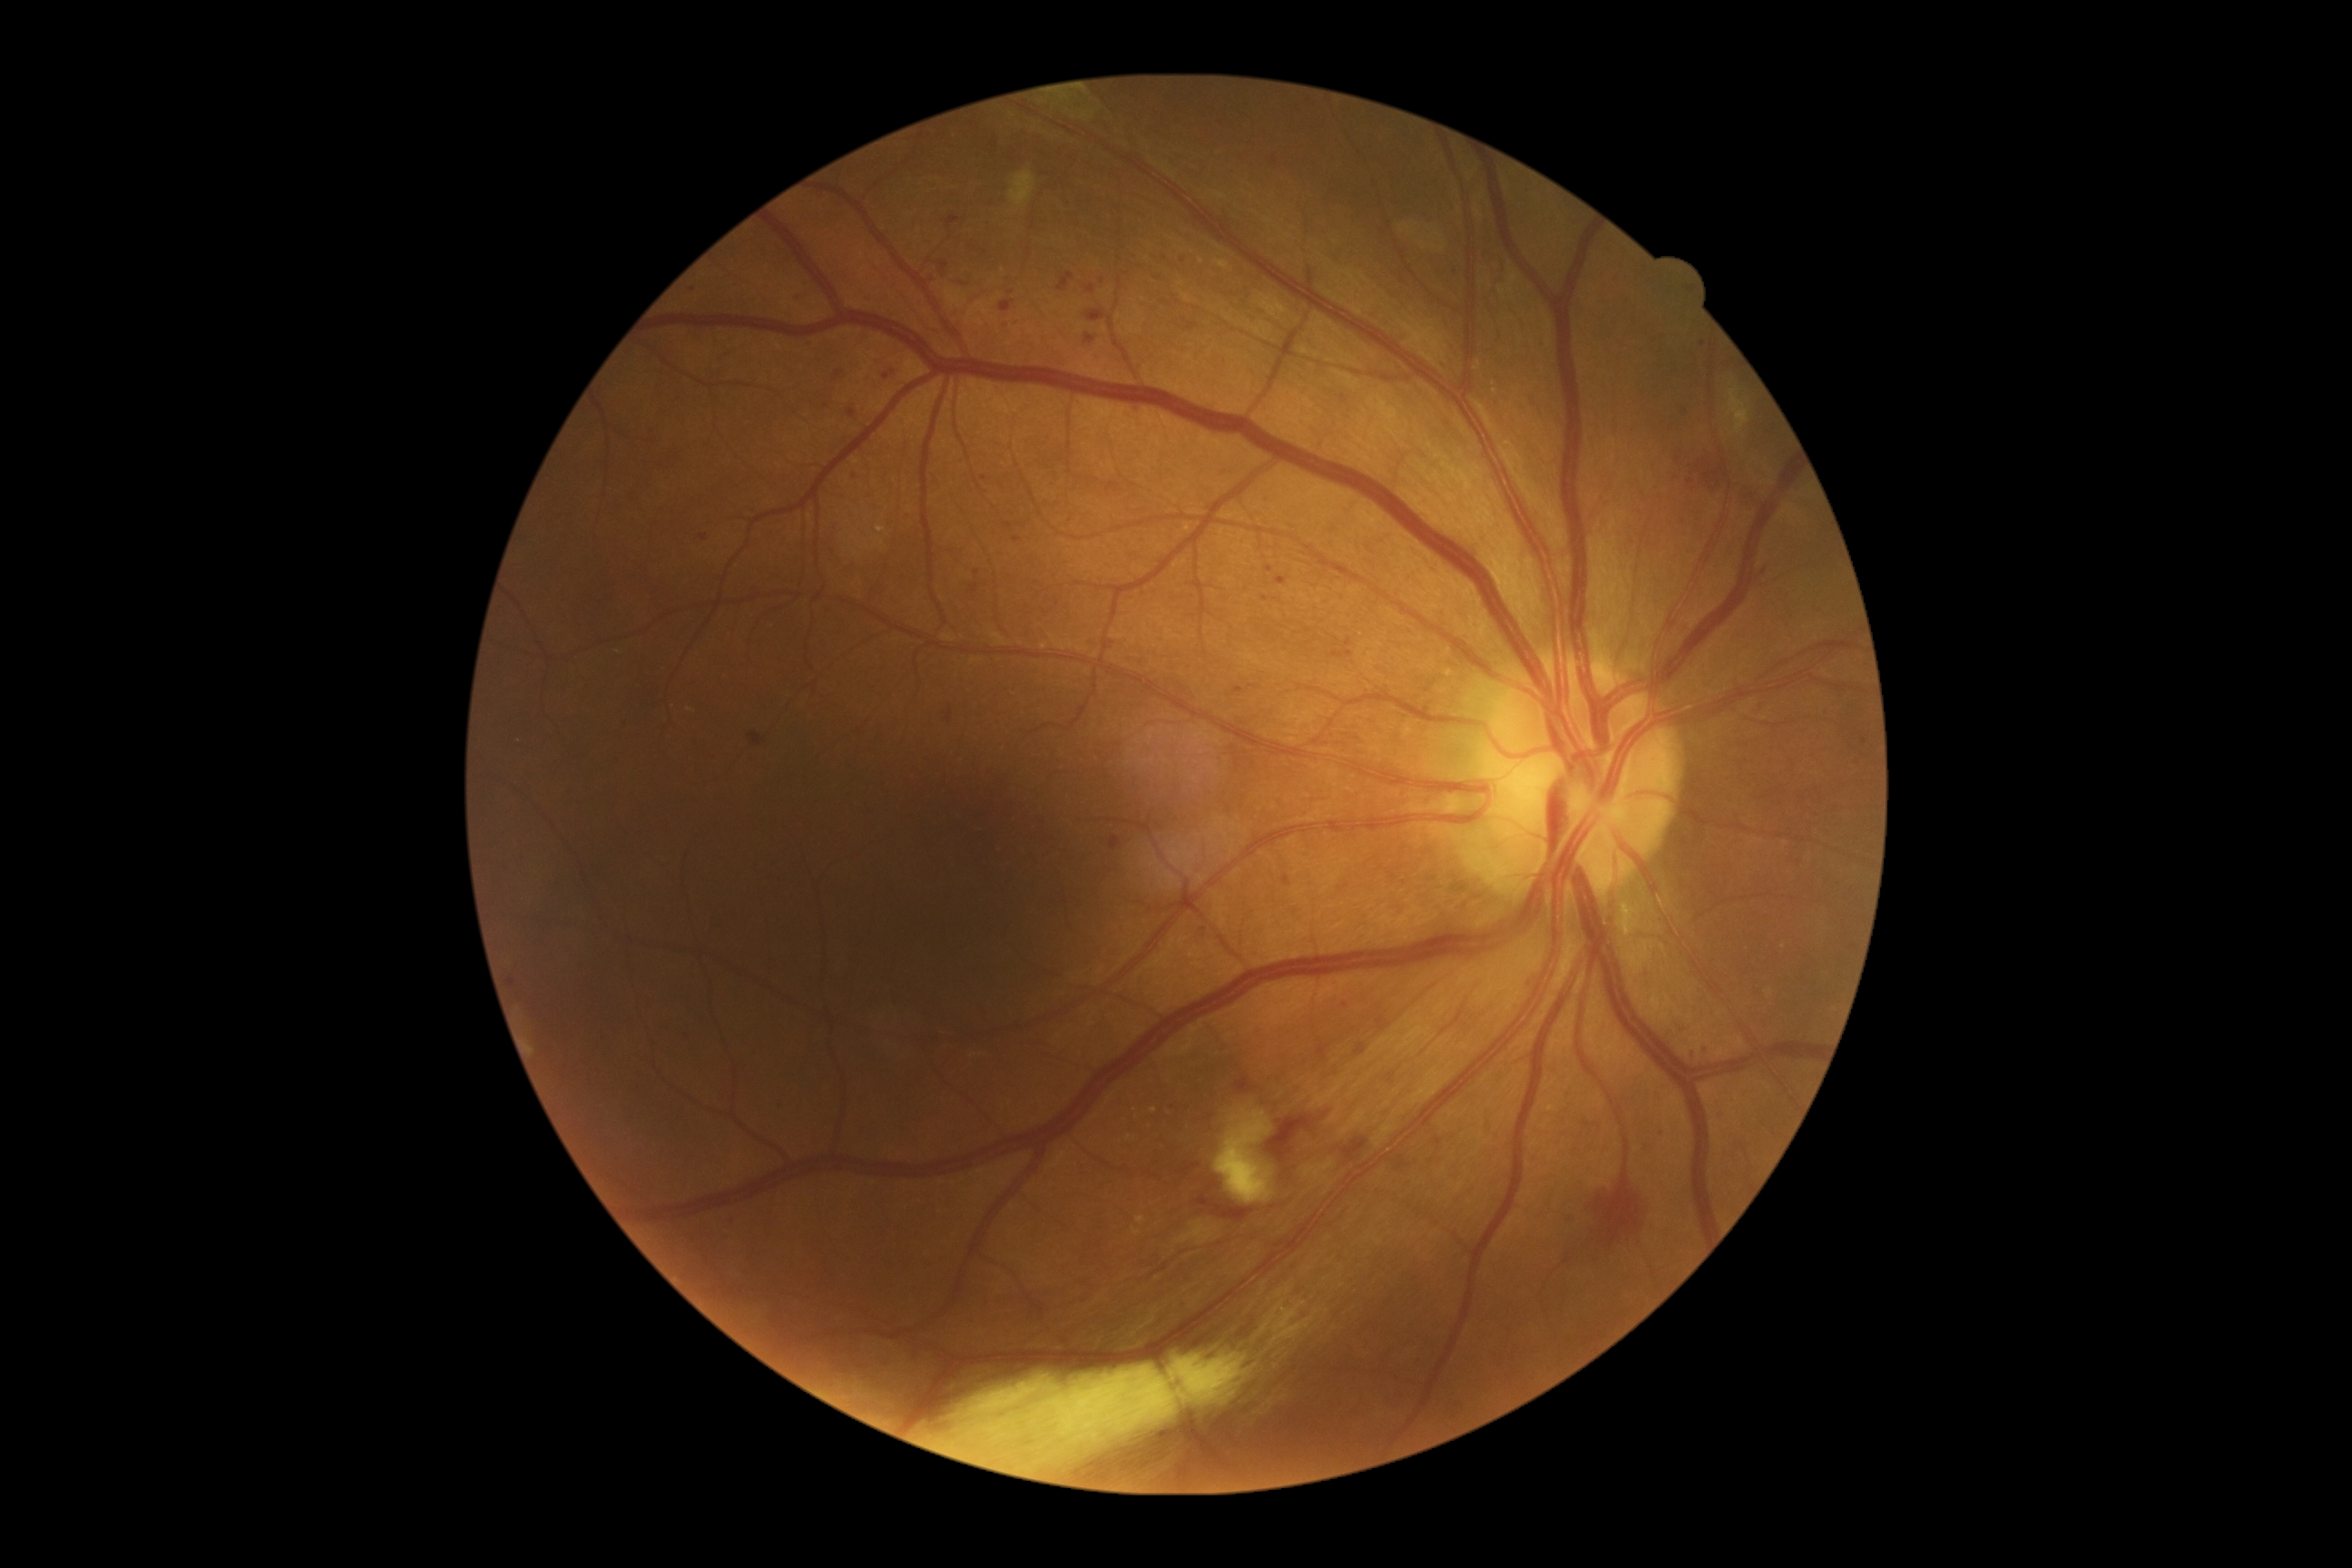 Diabetic retinopathy (DR): 2/4.